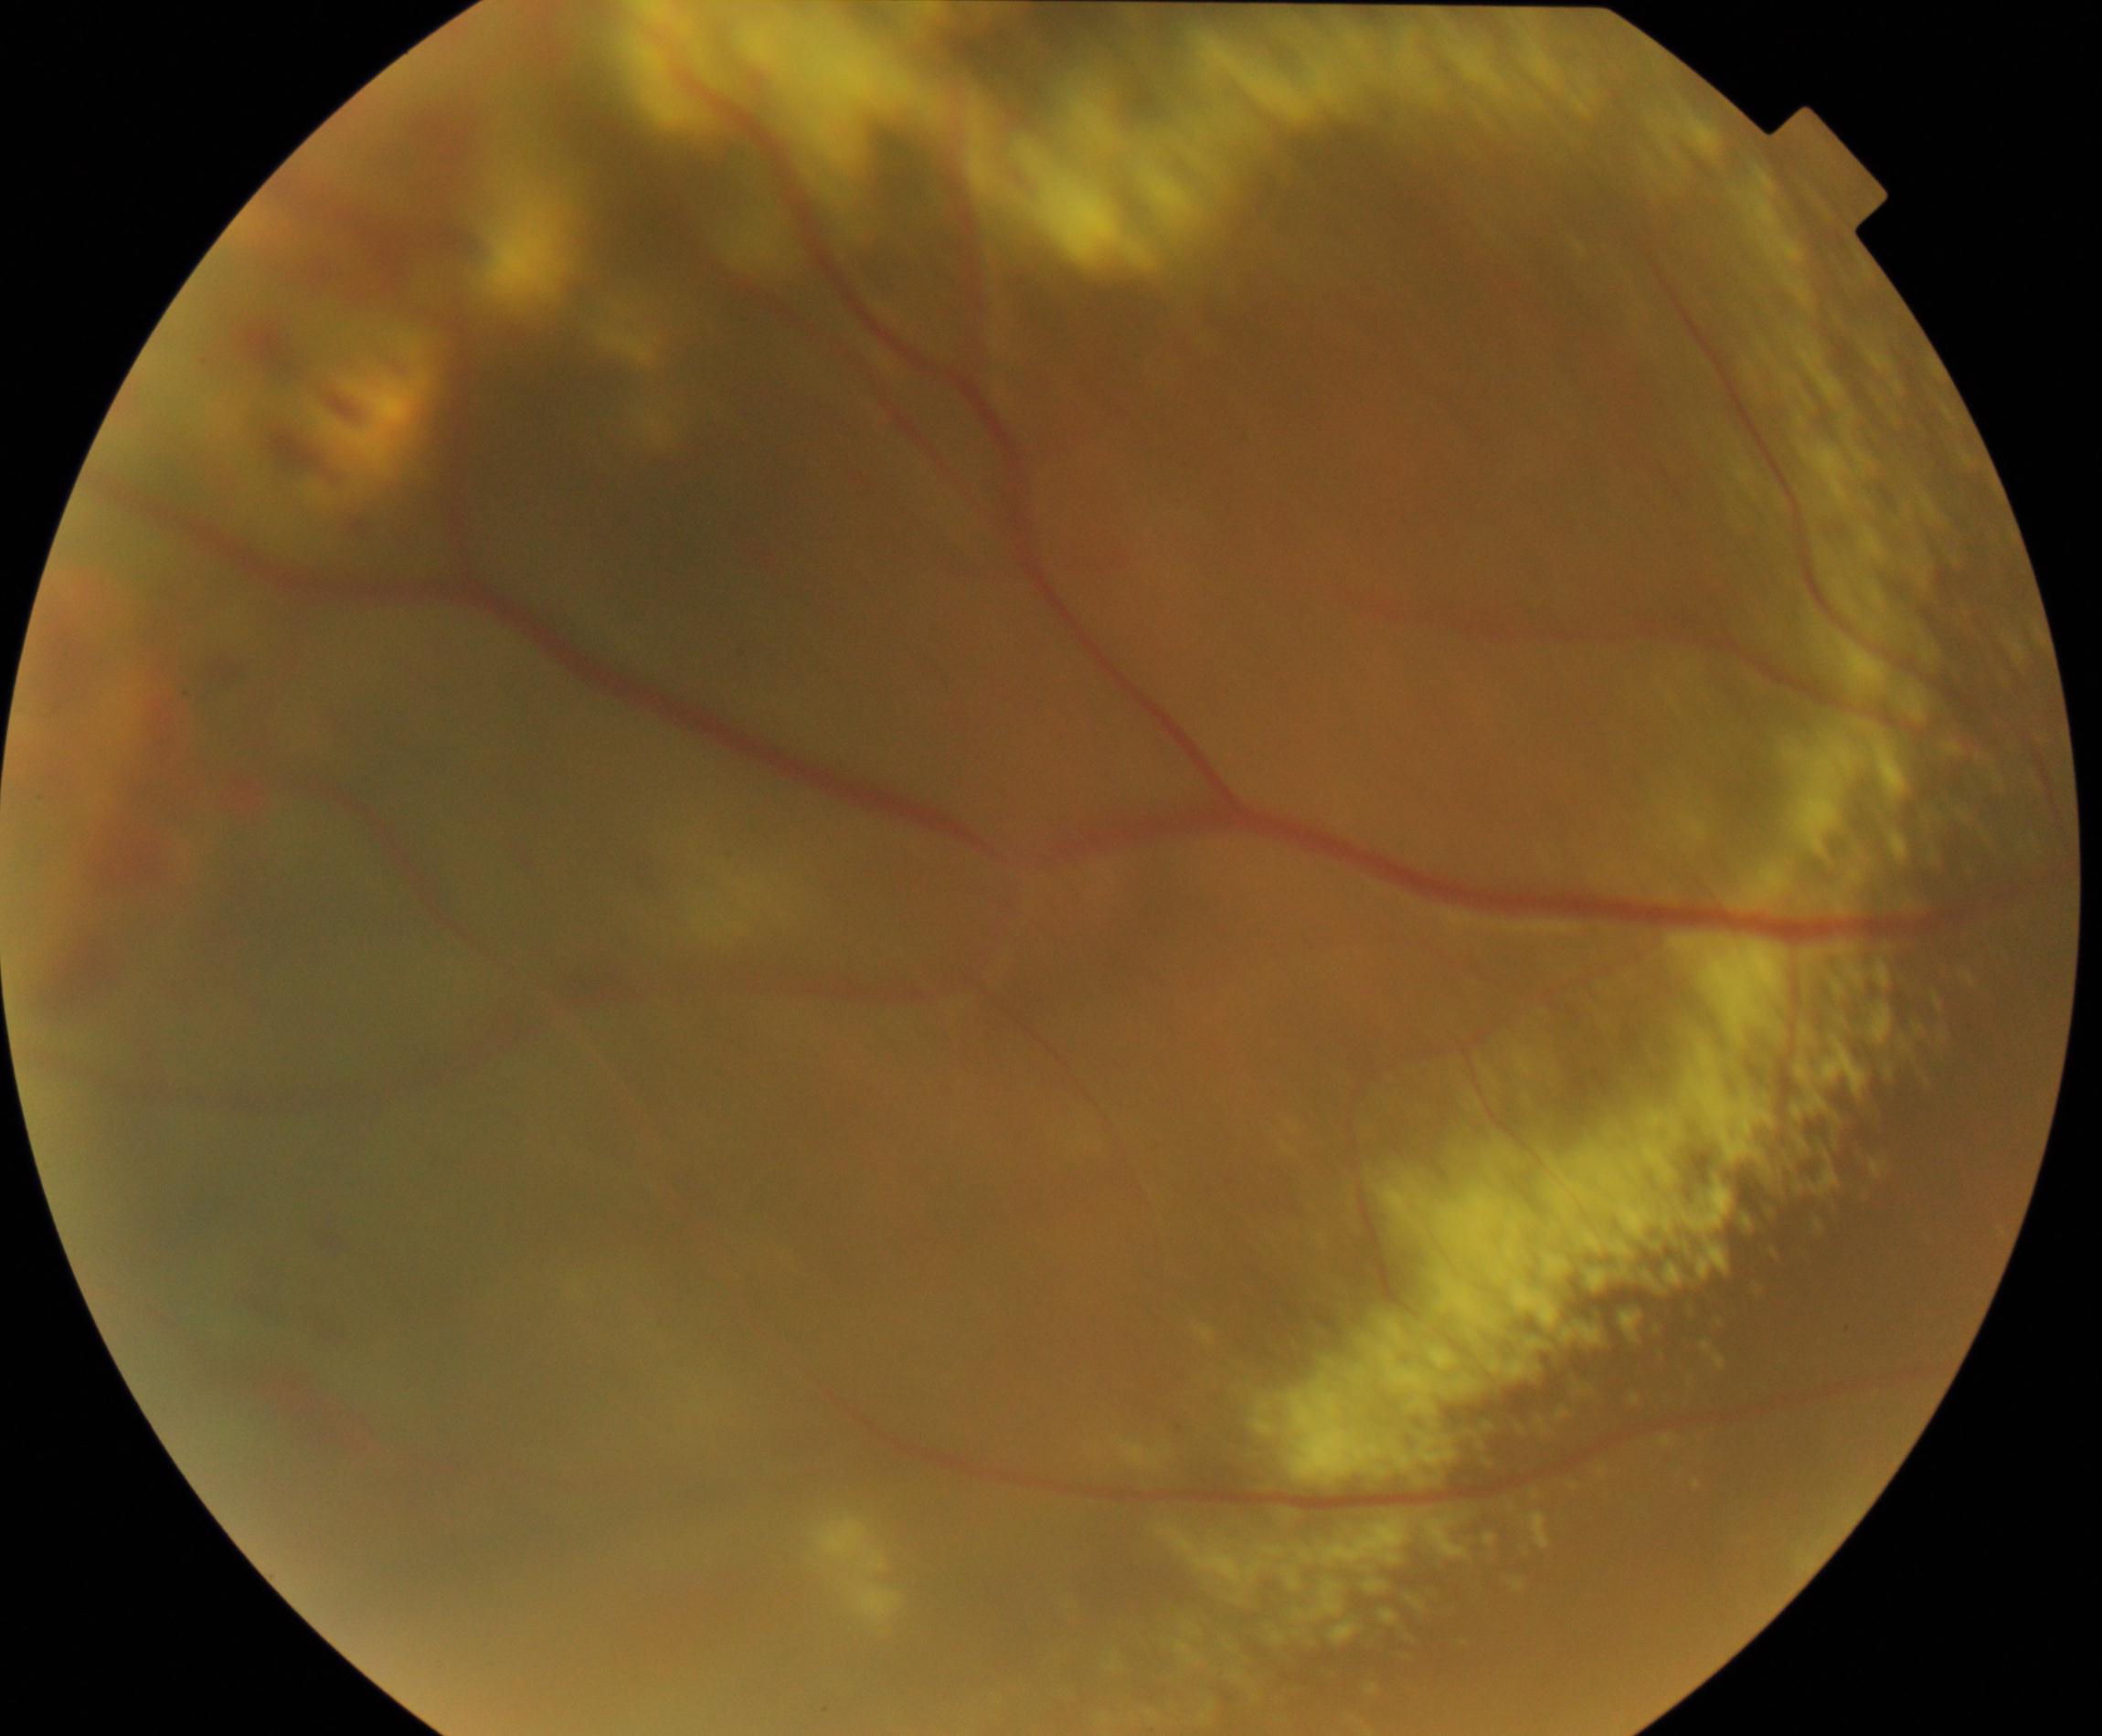

Classification: massive hard exudates.